Infant wide-field retinal image; 130° field of view (Clarity RetCam 3)
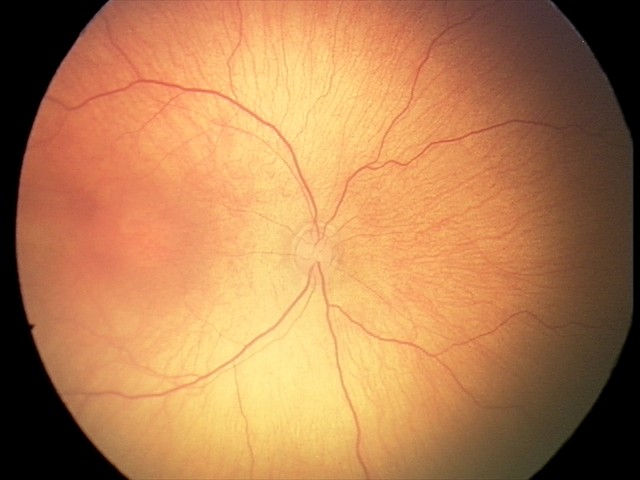 Diagnosis from this screening exam: retinopathy of prematurity stage 2.